45 degree fundus photograph — 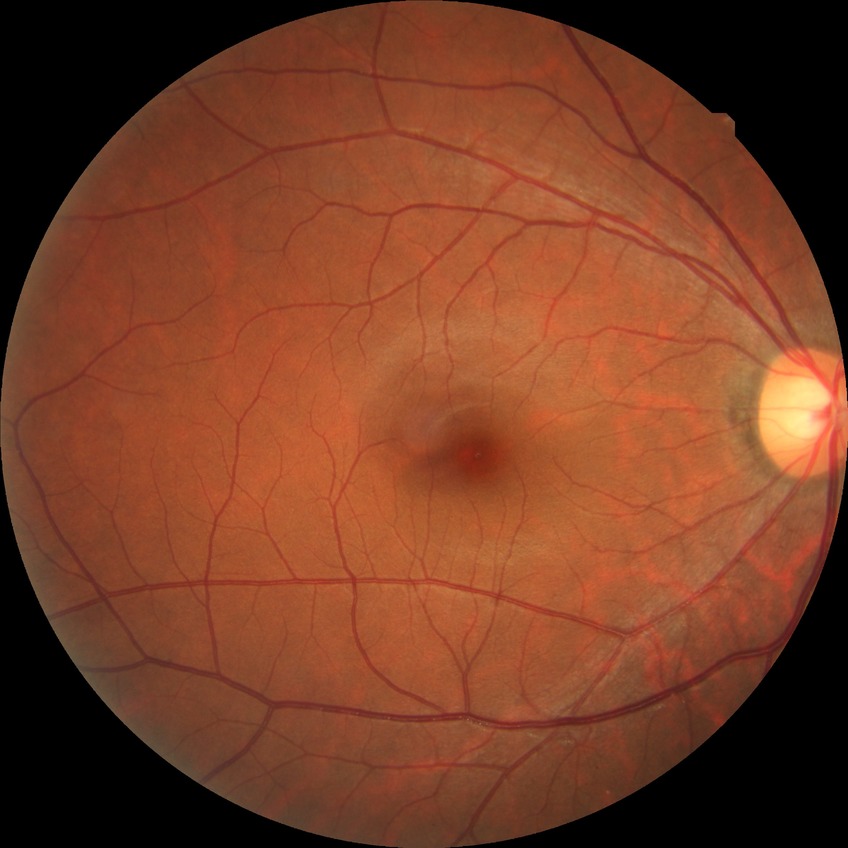

Davis grading: no diabetic retinopathy.